Posterior pole photograph. 45-degree field of view. Image size 848x848. Without pupil dilation. Camera: NIDEK AFC-230.
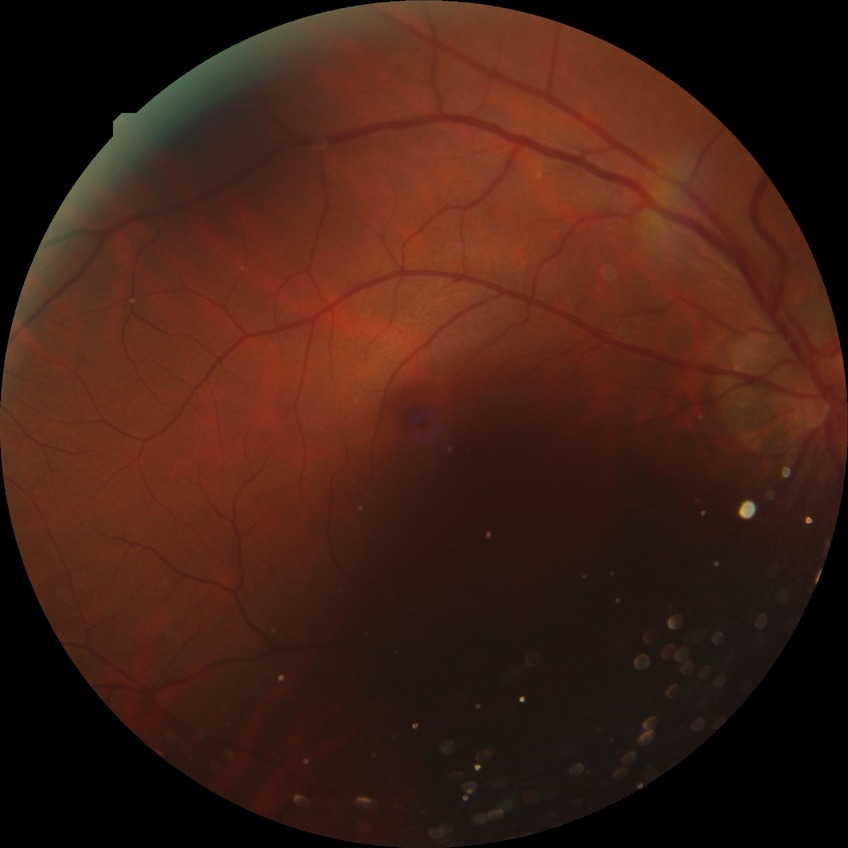 Modified Davis classification: no diabetic retinopathy.